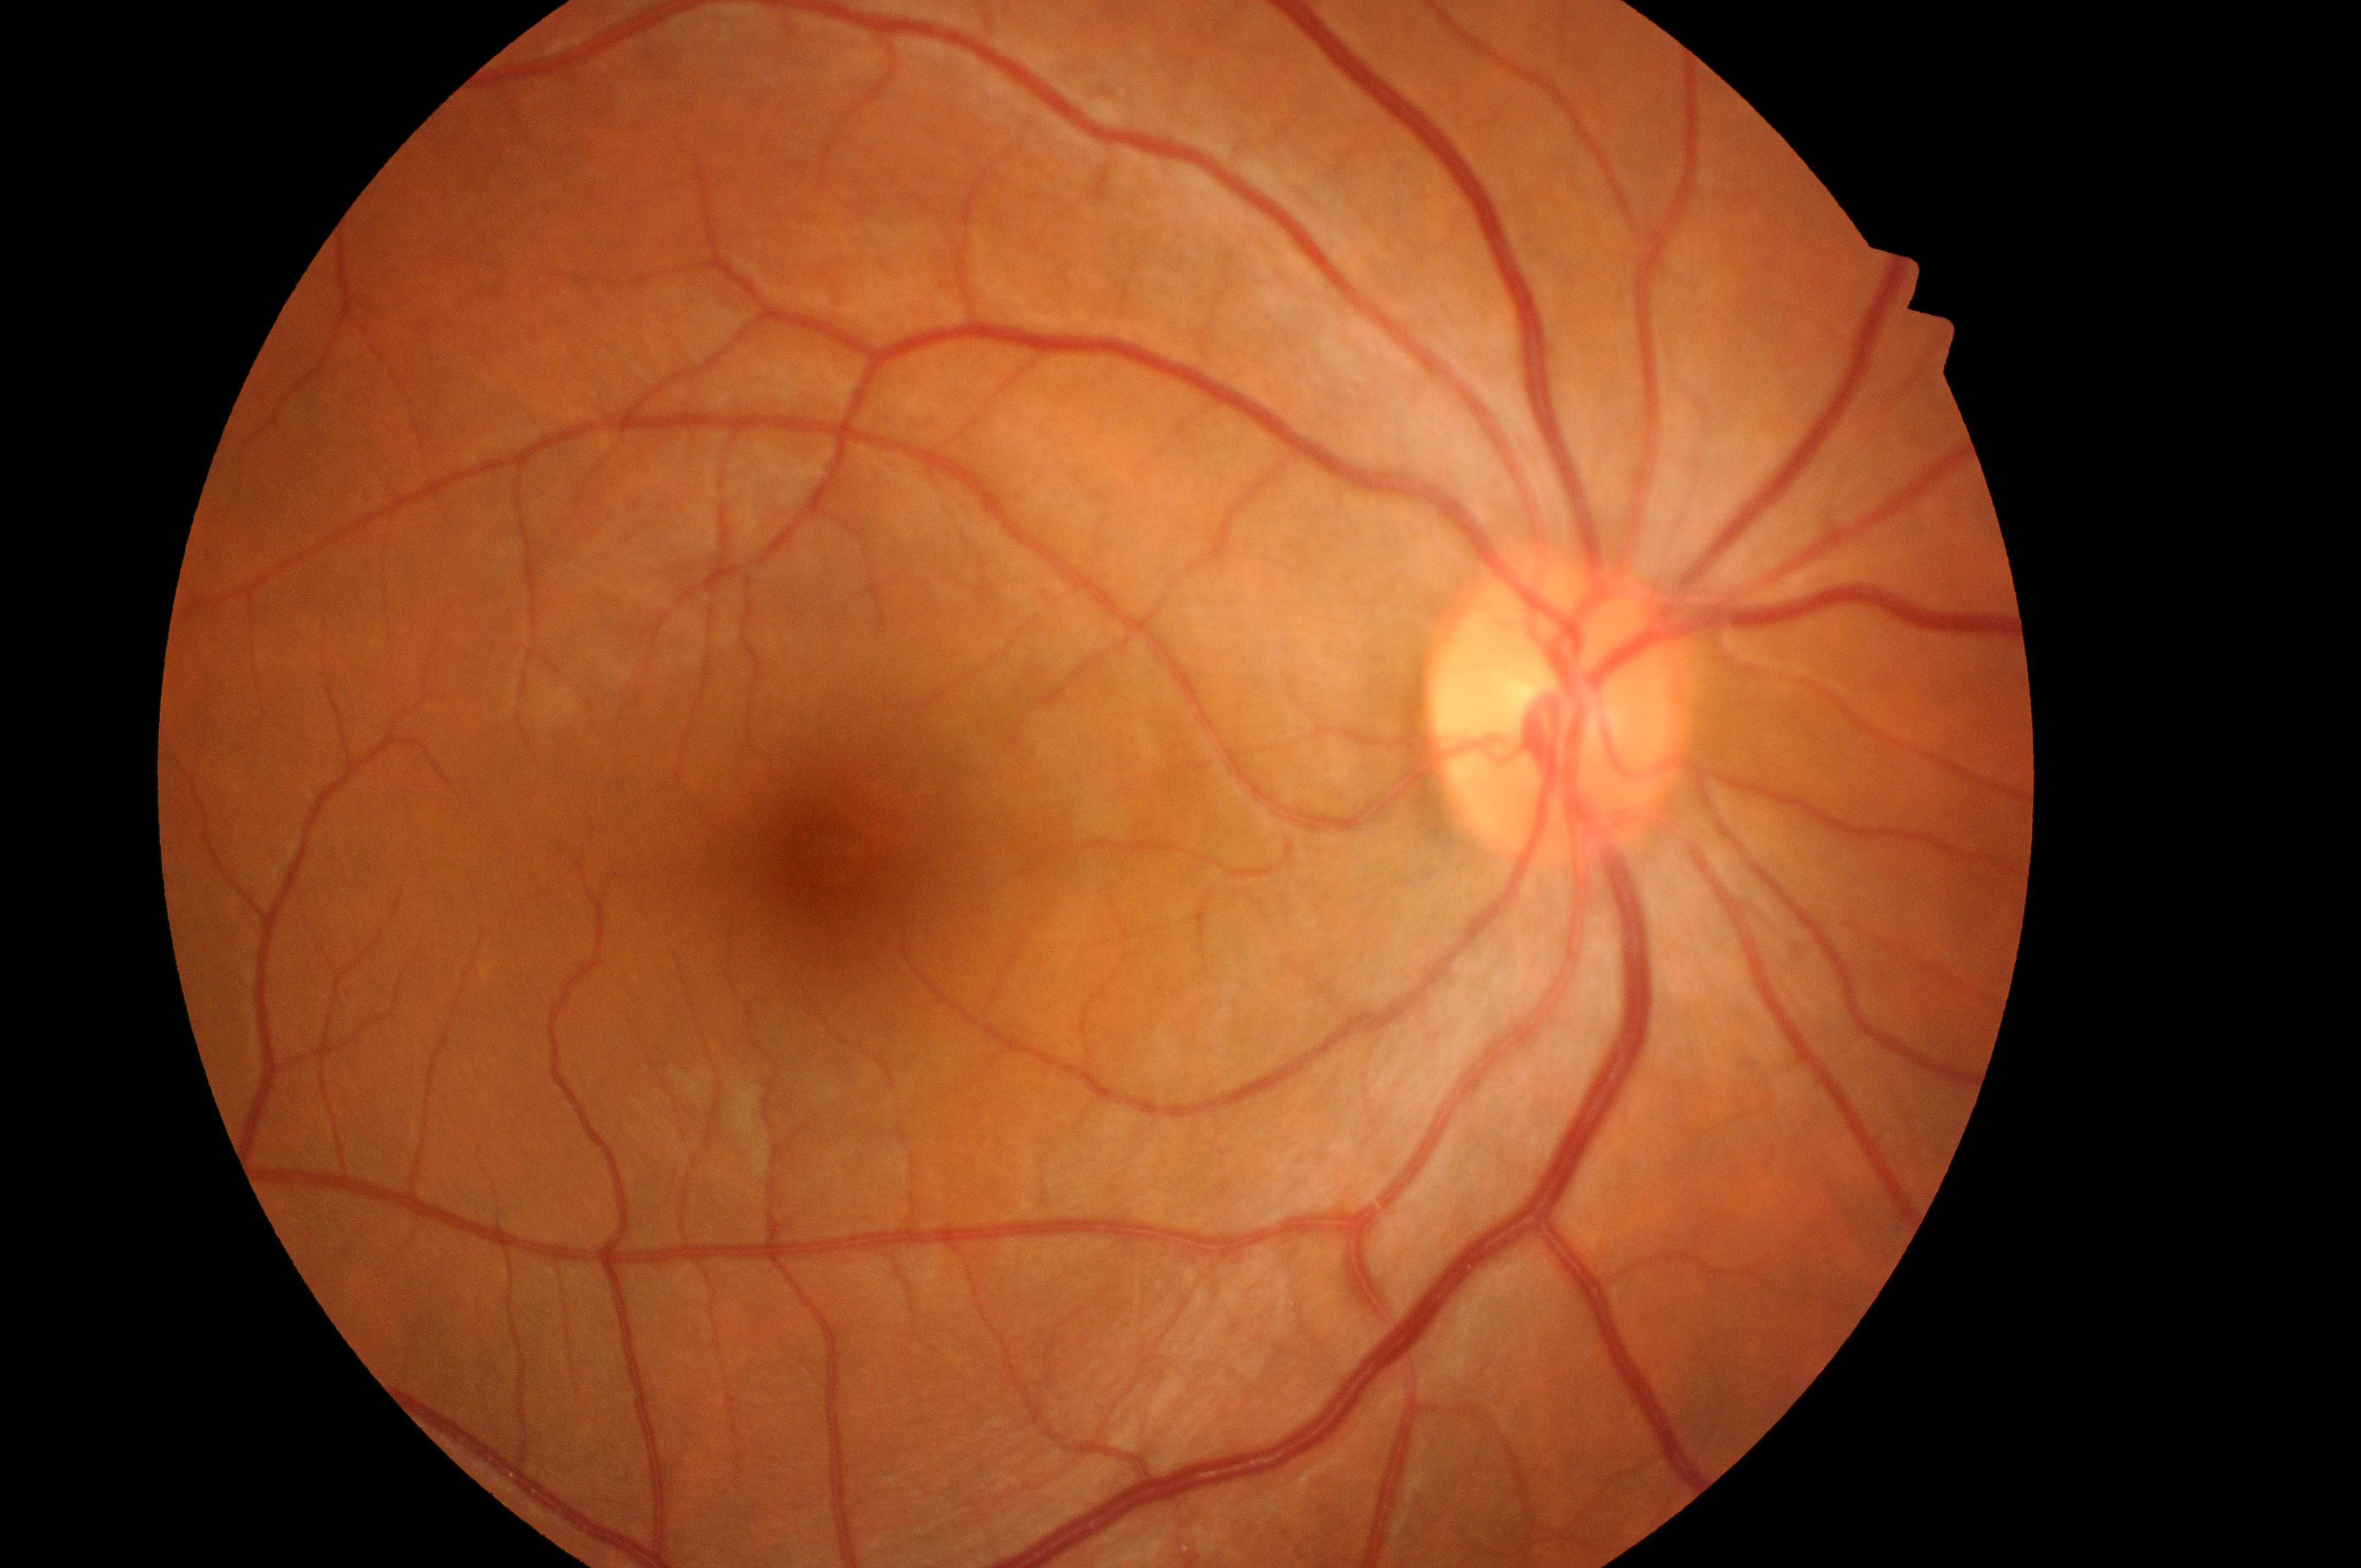
{
  "dr_grade": "0/4",
  "fovea": "(823, 851)",
  "dr_impression": "No signs of diabetic retinopathy or diabetic macular edema",
  "optic_disc": "(1555, 726)",
  "eye": "right",
  "dme_grade": "0"
}